Captured after pupil dilation.
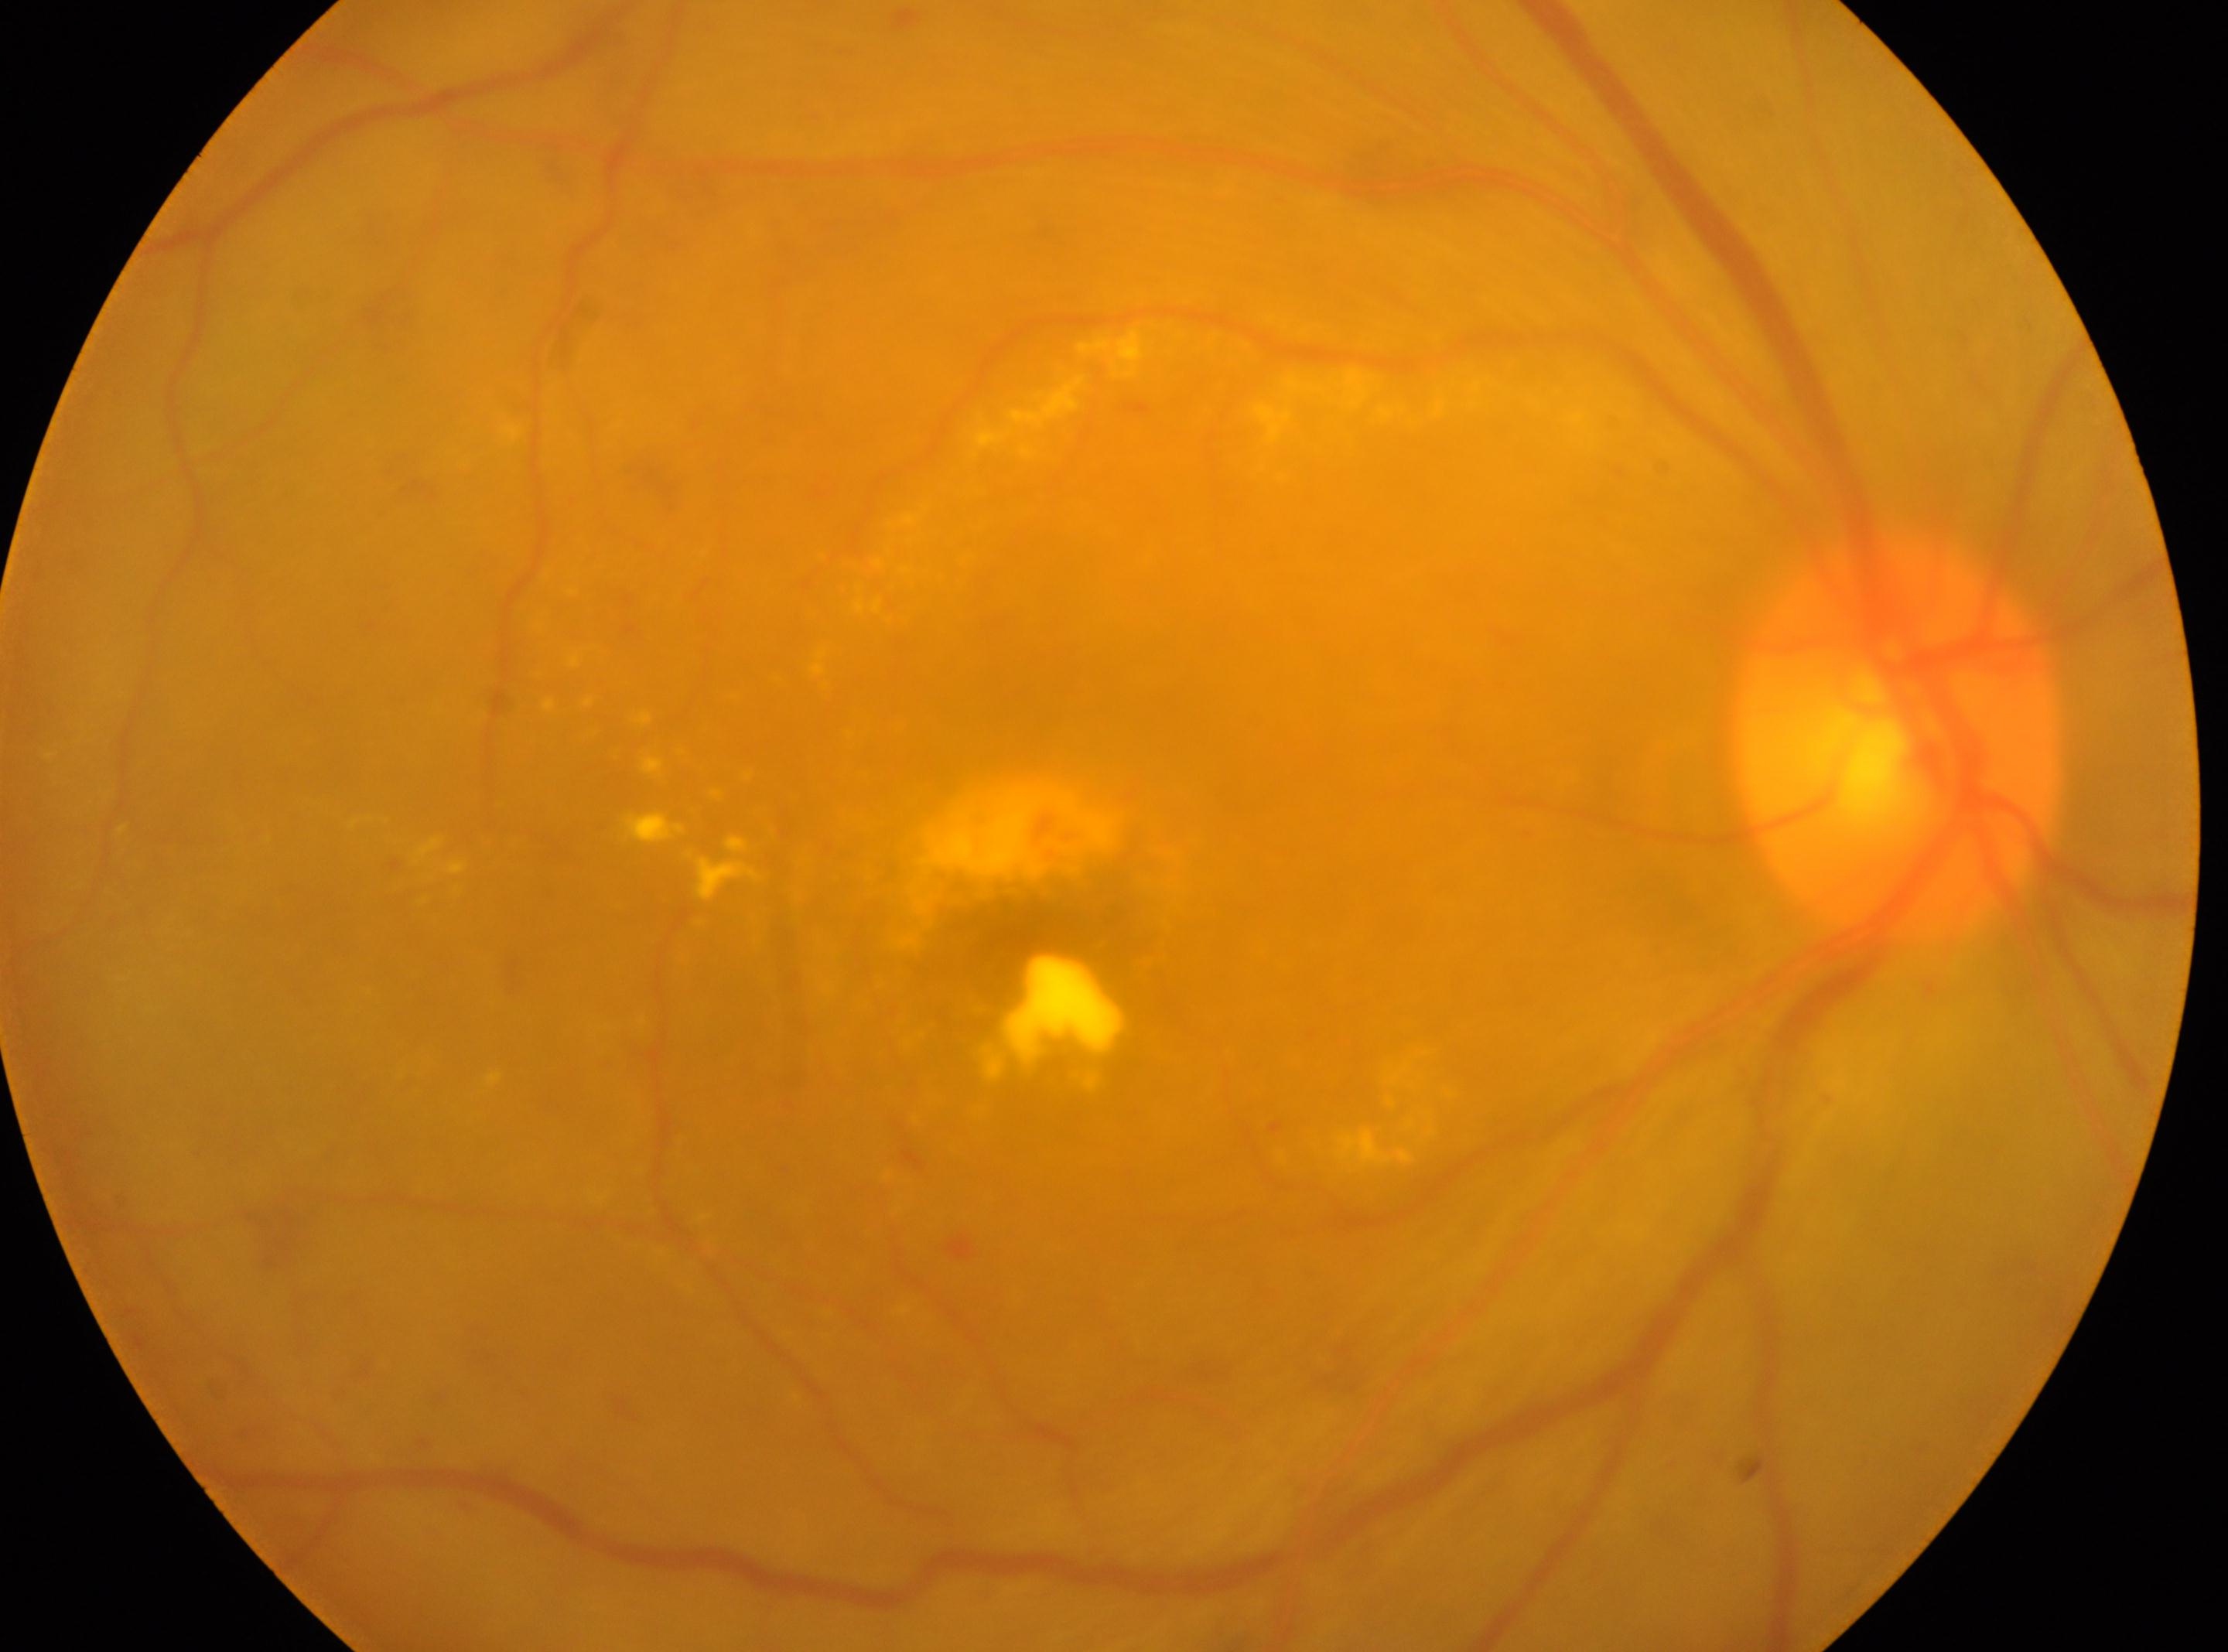

Findings:
– optic disc center: (1898,741)
– diabetic retinopathy (DR): grade 2 (moderate NPDR)
– macula center: (1023,934)
– laterality: oculus dexter